Retinal fundus photograph:
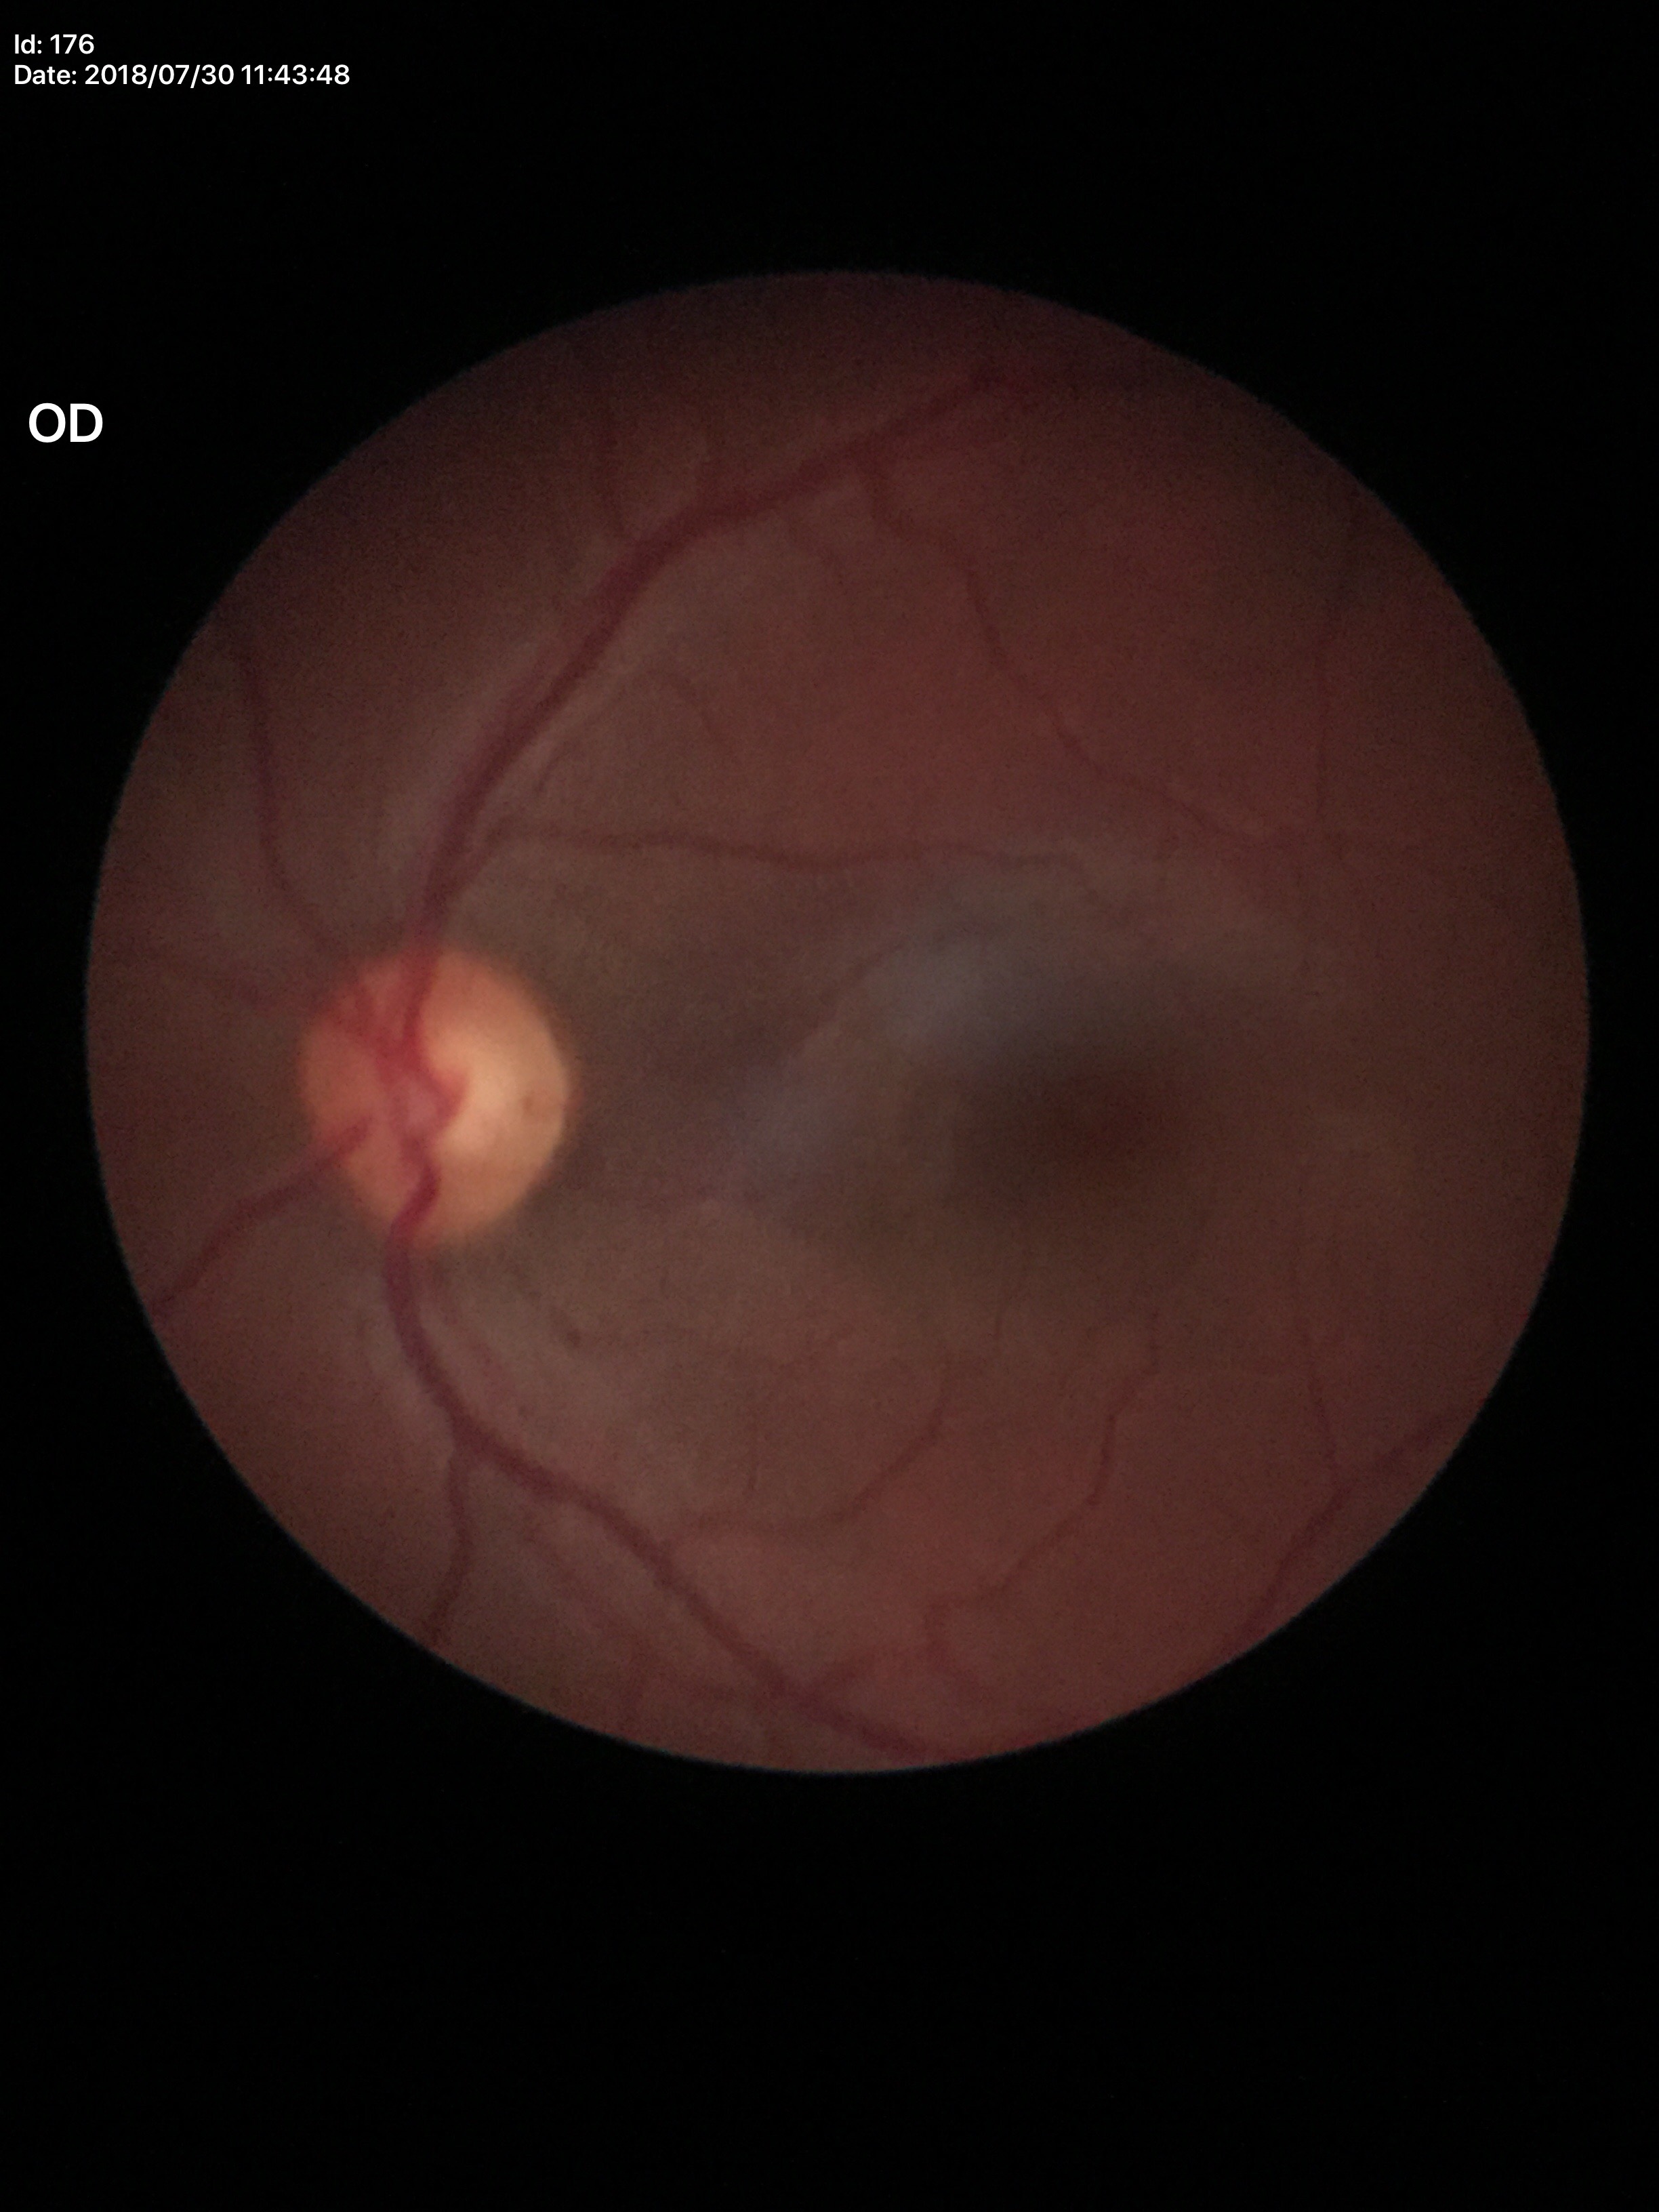
  vcdr: 0.53
  glaucoma_decision: no suspicious findings